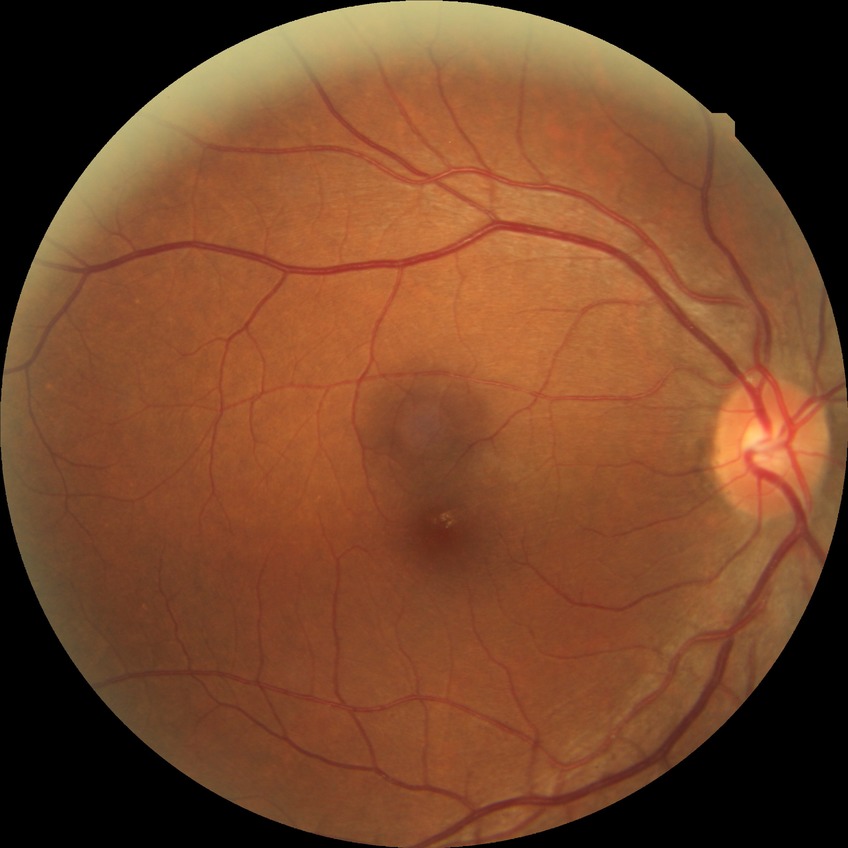
• diabetic retinopathy (DR) — no diabetic retinopathy (NDR)